2212x1659px · 45-degree field of view · CFP — 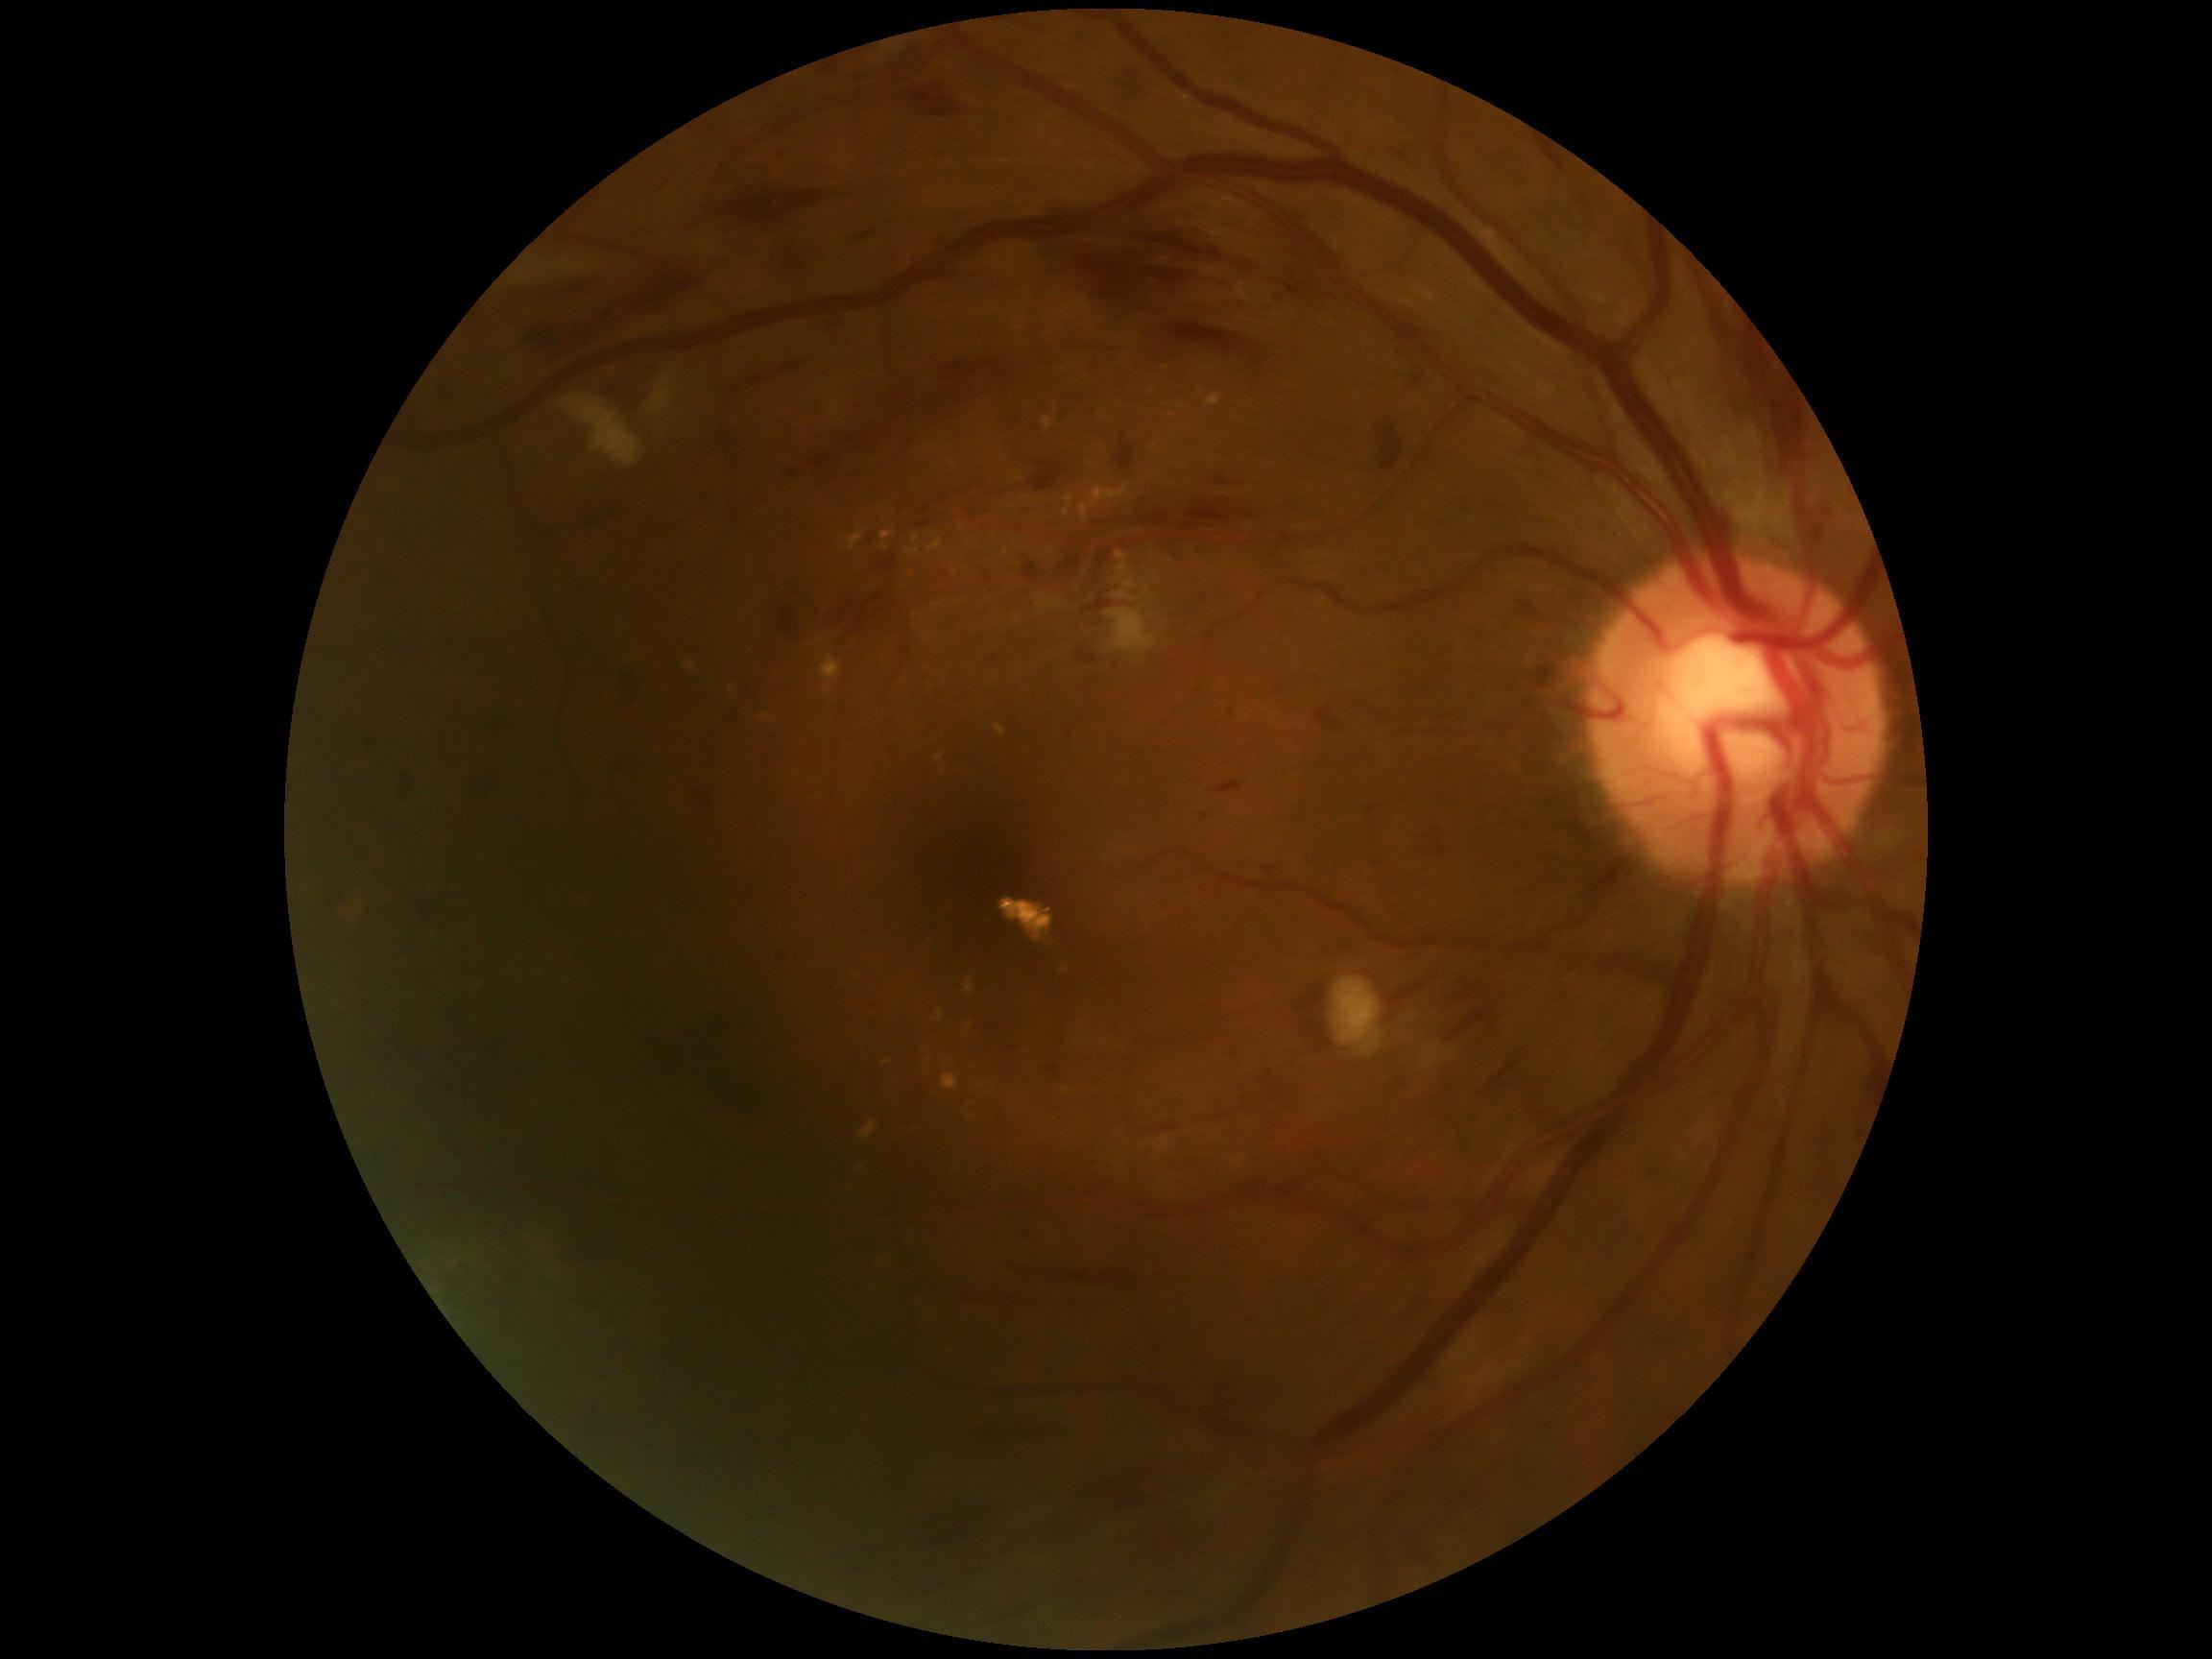

DR: grade 3 (severe NPDR).